FOV: 45 degrees, fundus photo
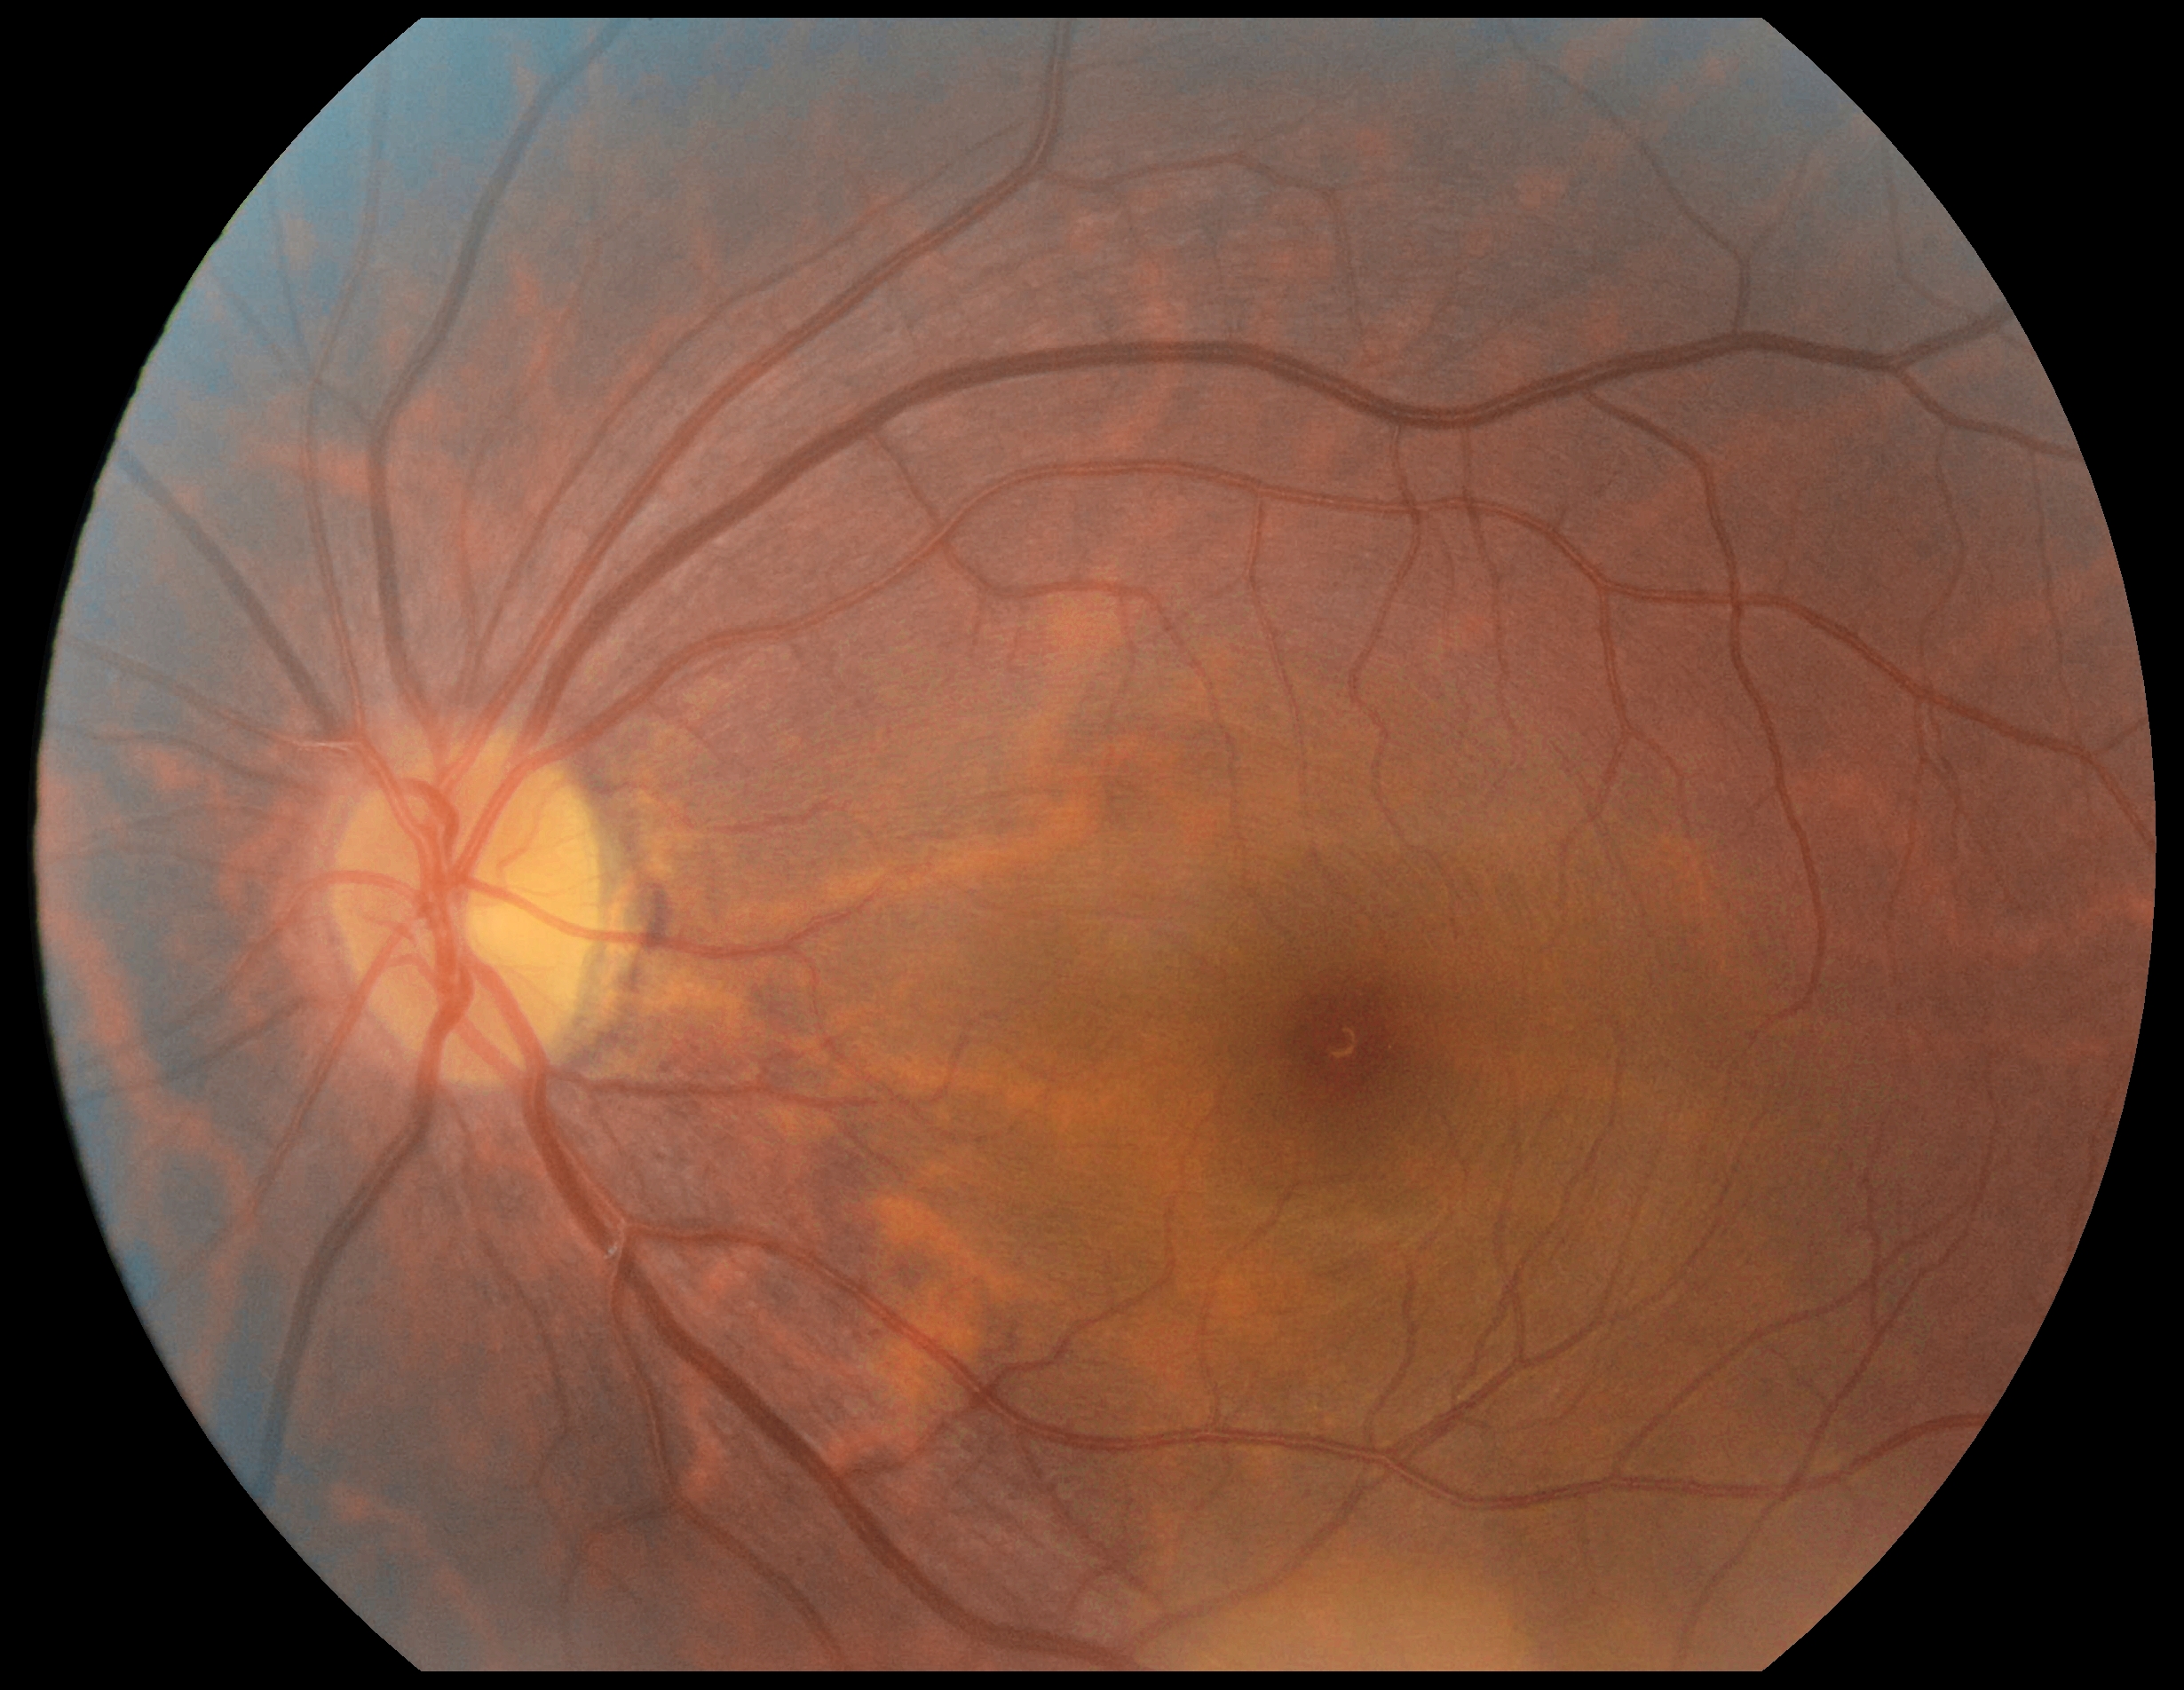
Diabetic retinopathy is grade 0 (no apparent retinopathy). No apparent diabetic retinopathy.